No pharmacologic dilation. 45-degree field of view. Camera: NIDEK AFC-230. Posterior pole color fundus photograph — 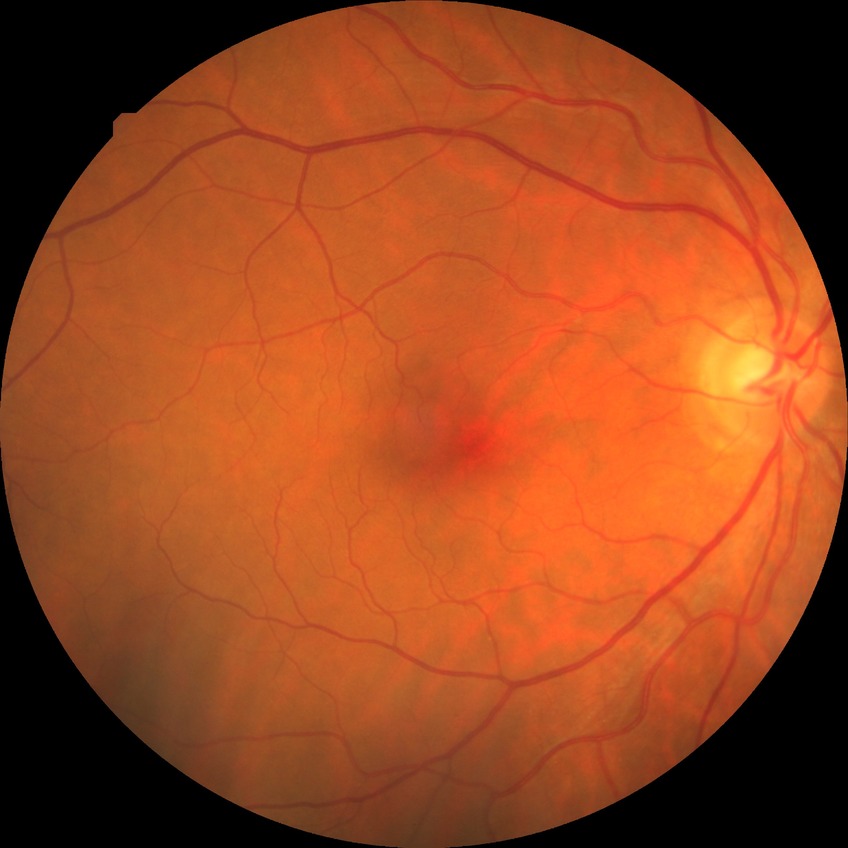

DR stage: NDR.